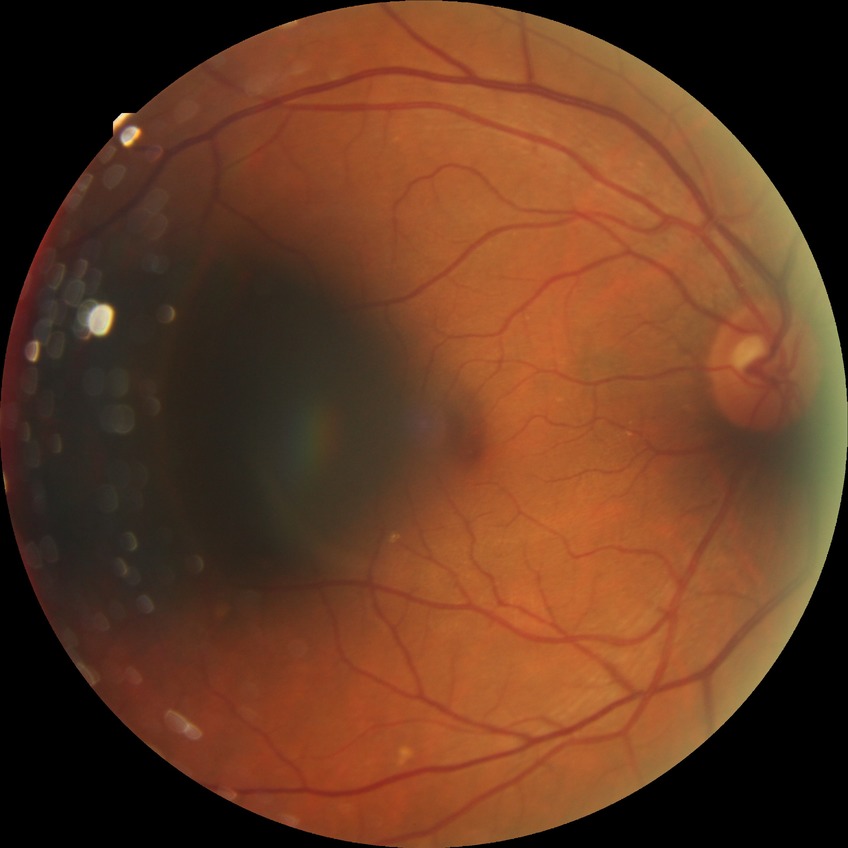

diabetic retinopathy (DR): no diabetic retinopathy (NDR).